CFP, 2048x1536, 45° FOV
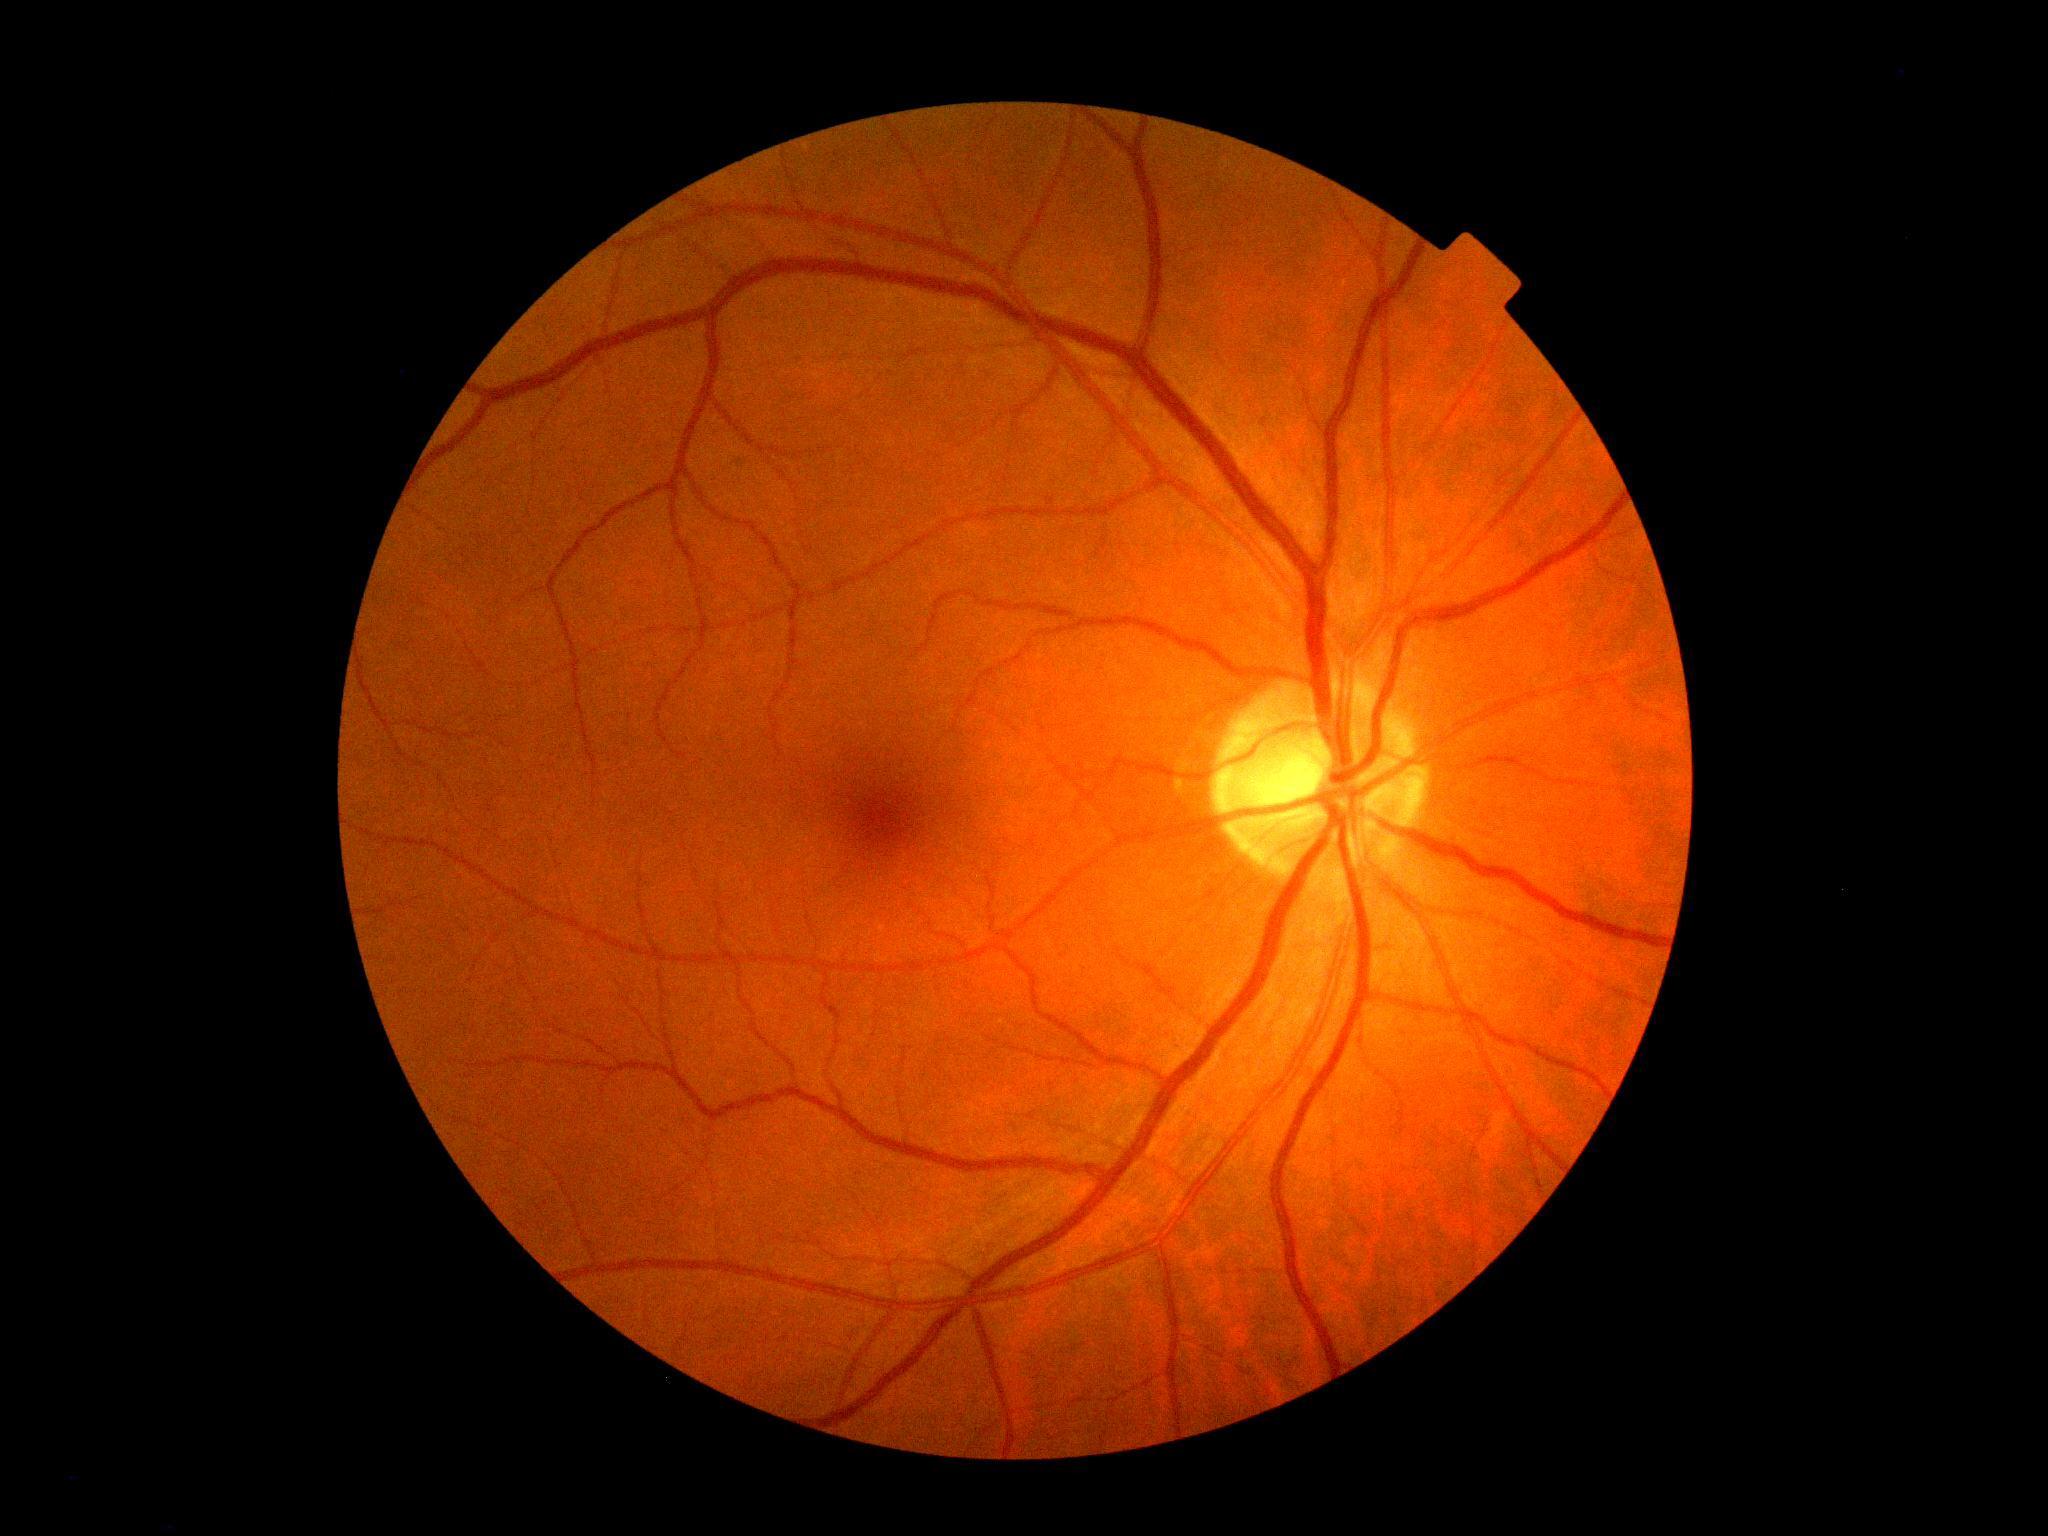

{
  "dr_grade": "0/4",
  "dr_impression": "negative for DR"
}